FOV: 45 degrees
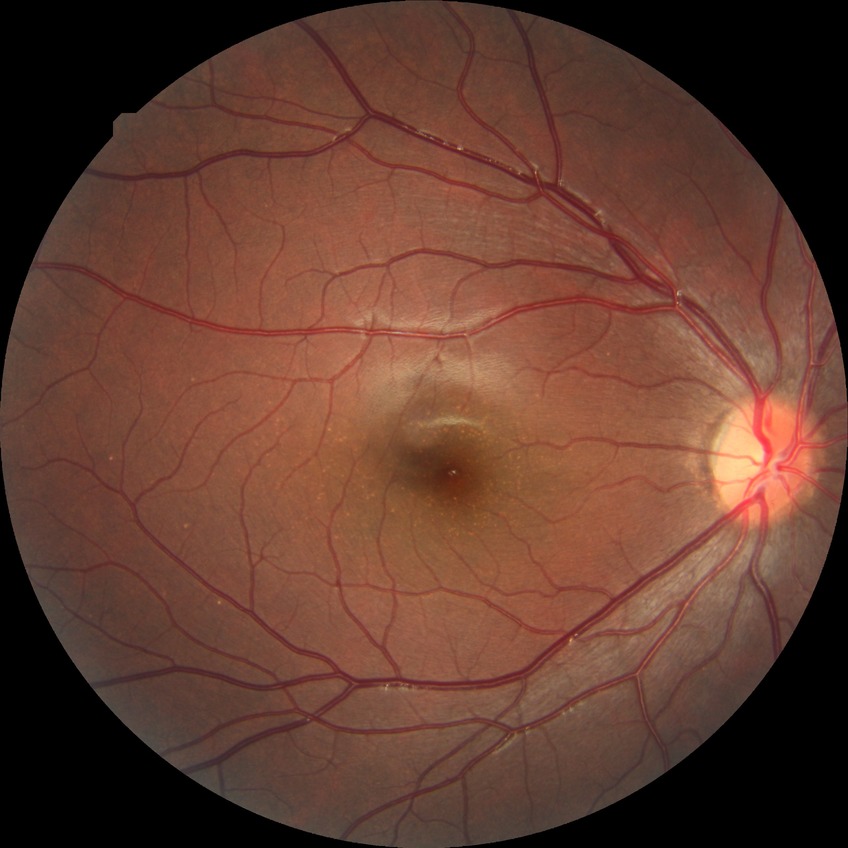
Retinopathy stage is no diabetic retinopathy.